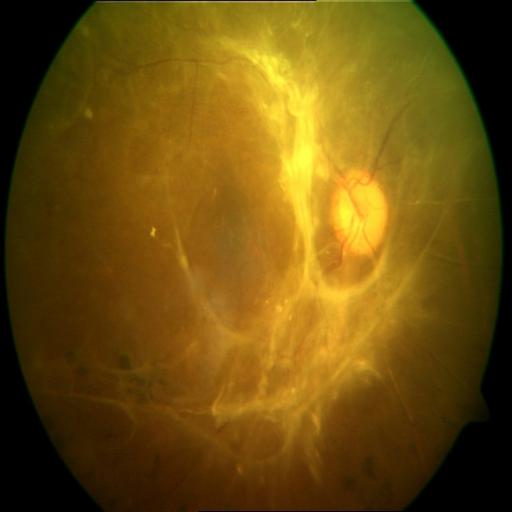
Fundus appearance consistent with RT (retinal traction).